2100 by 1592 pixels:
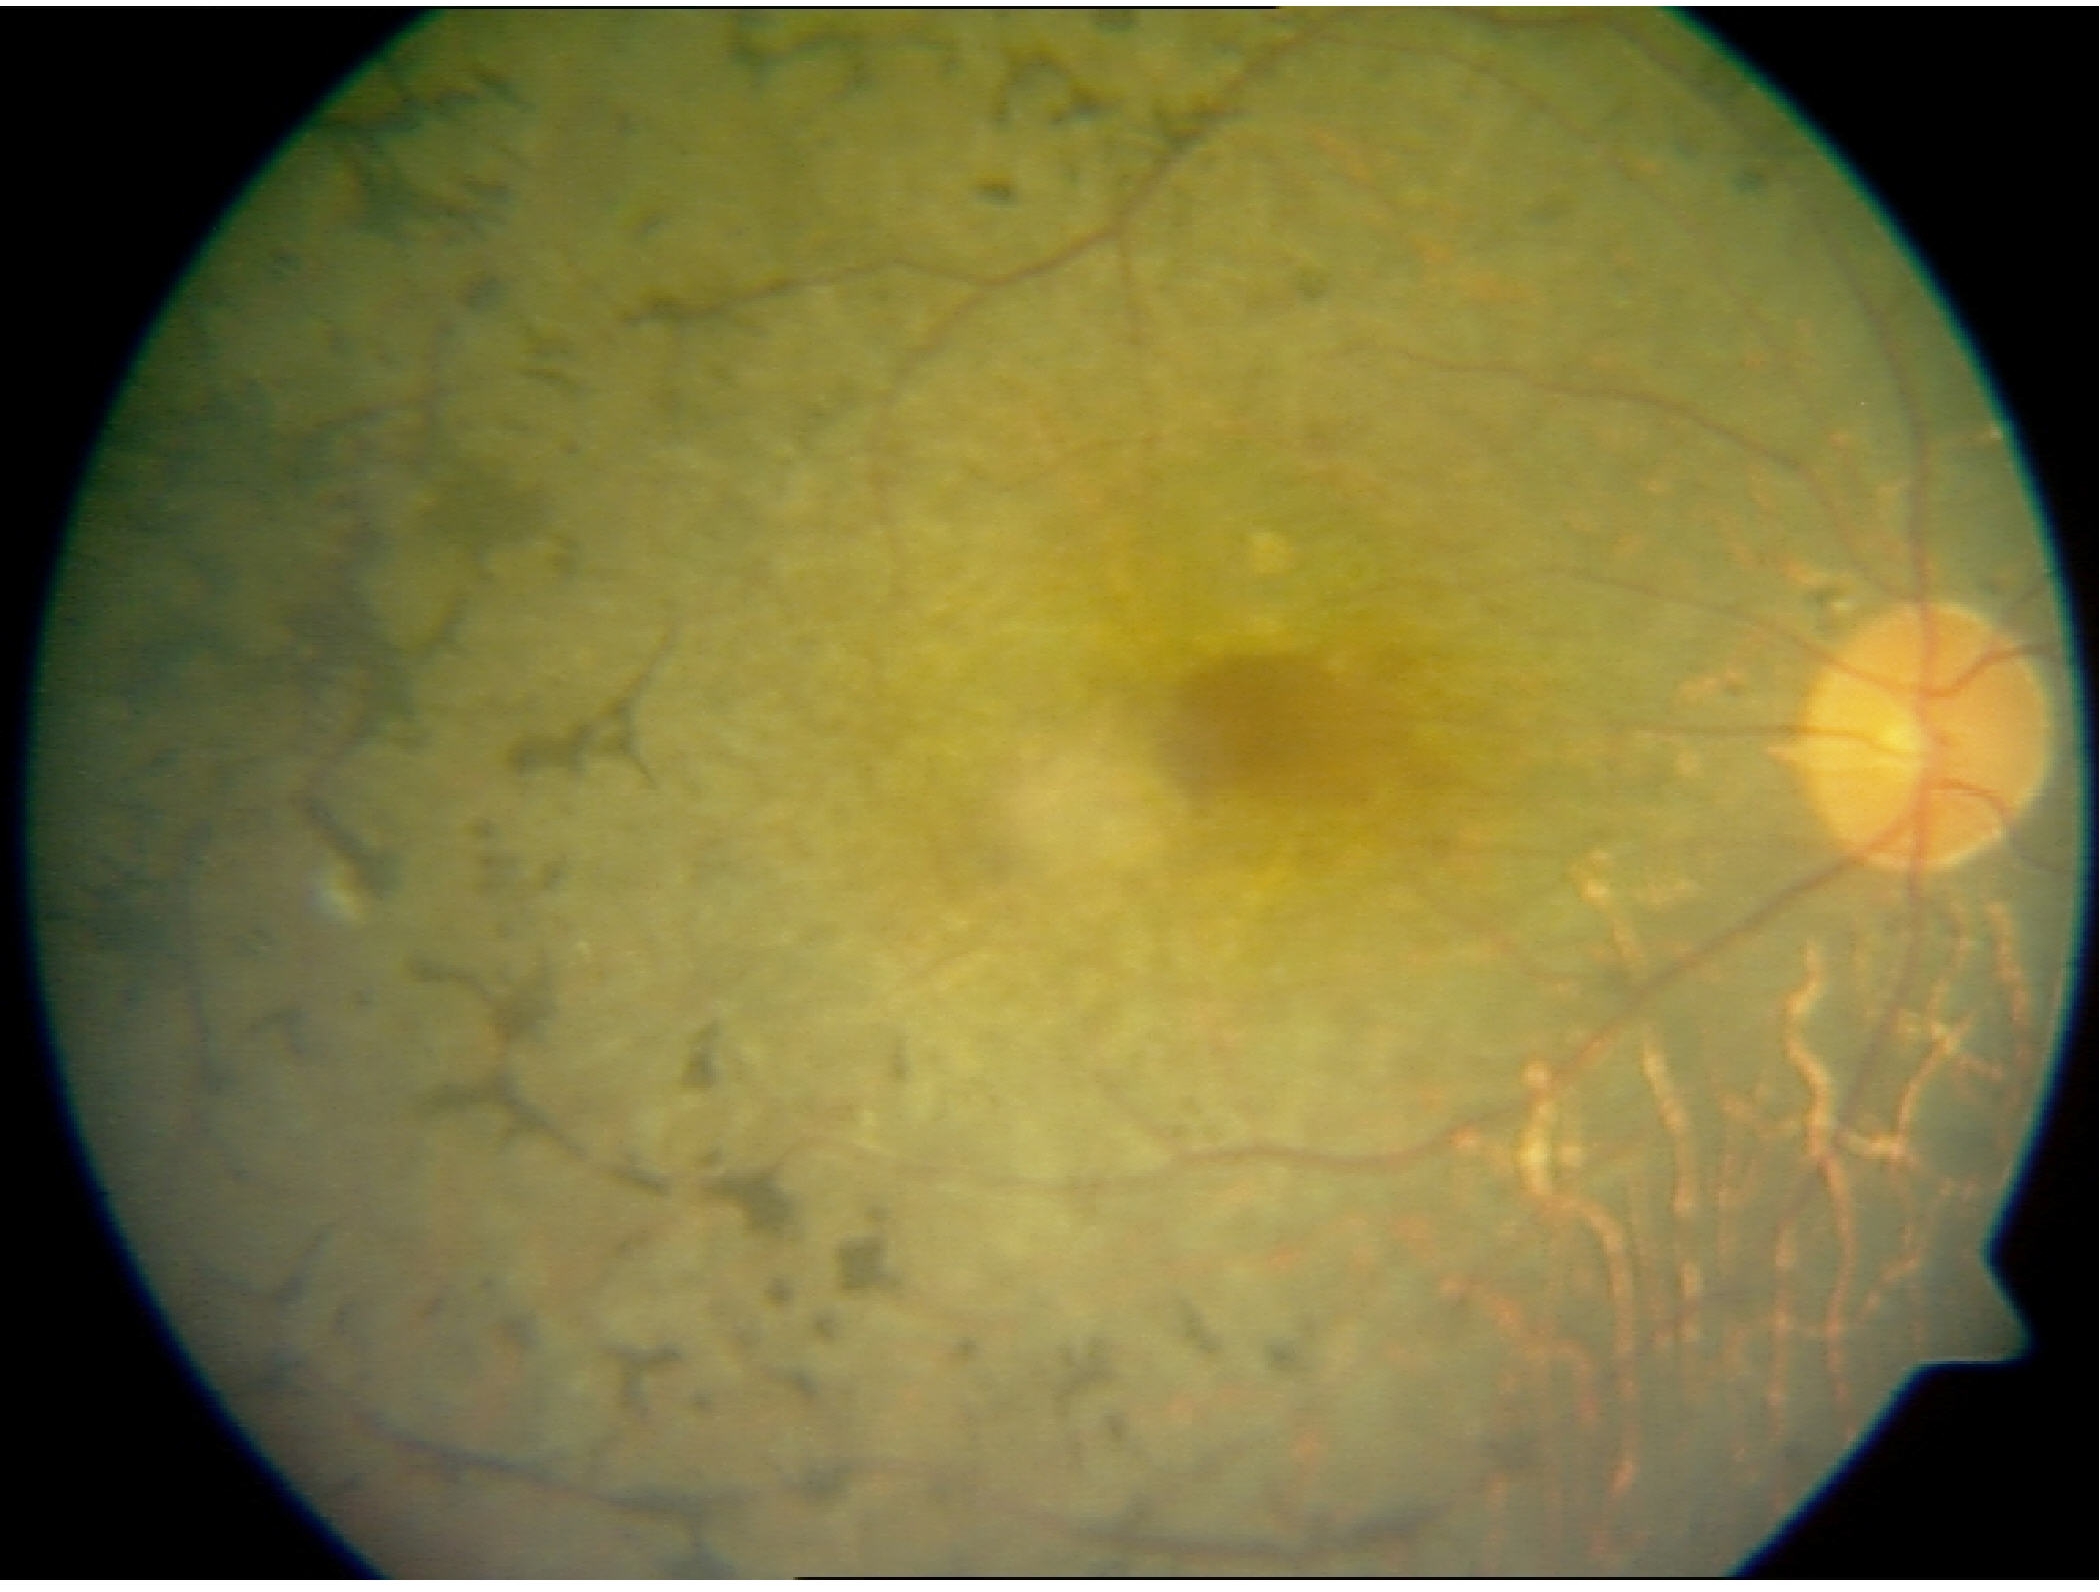
Classification: retinitis pigmentosa. Typically showing mid-peripheral retinal pigment epithelium atrophy with bone-spicule perivascular pigmentation, arteriolar attenuation, and waxy disc pallor.